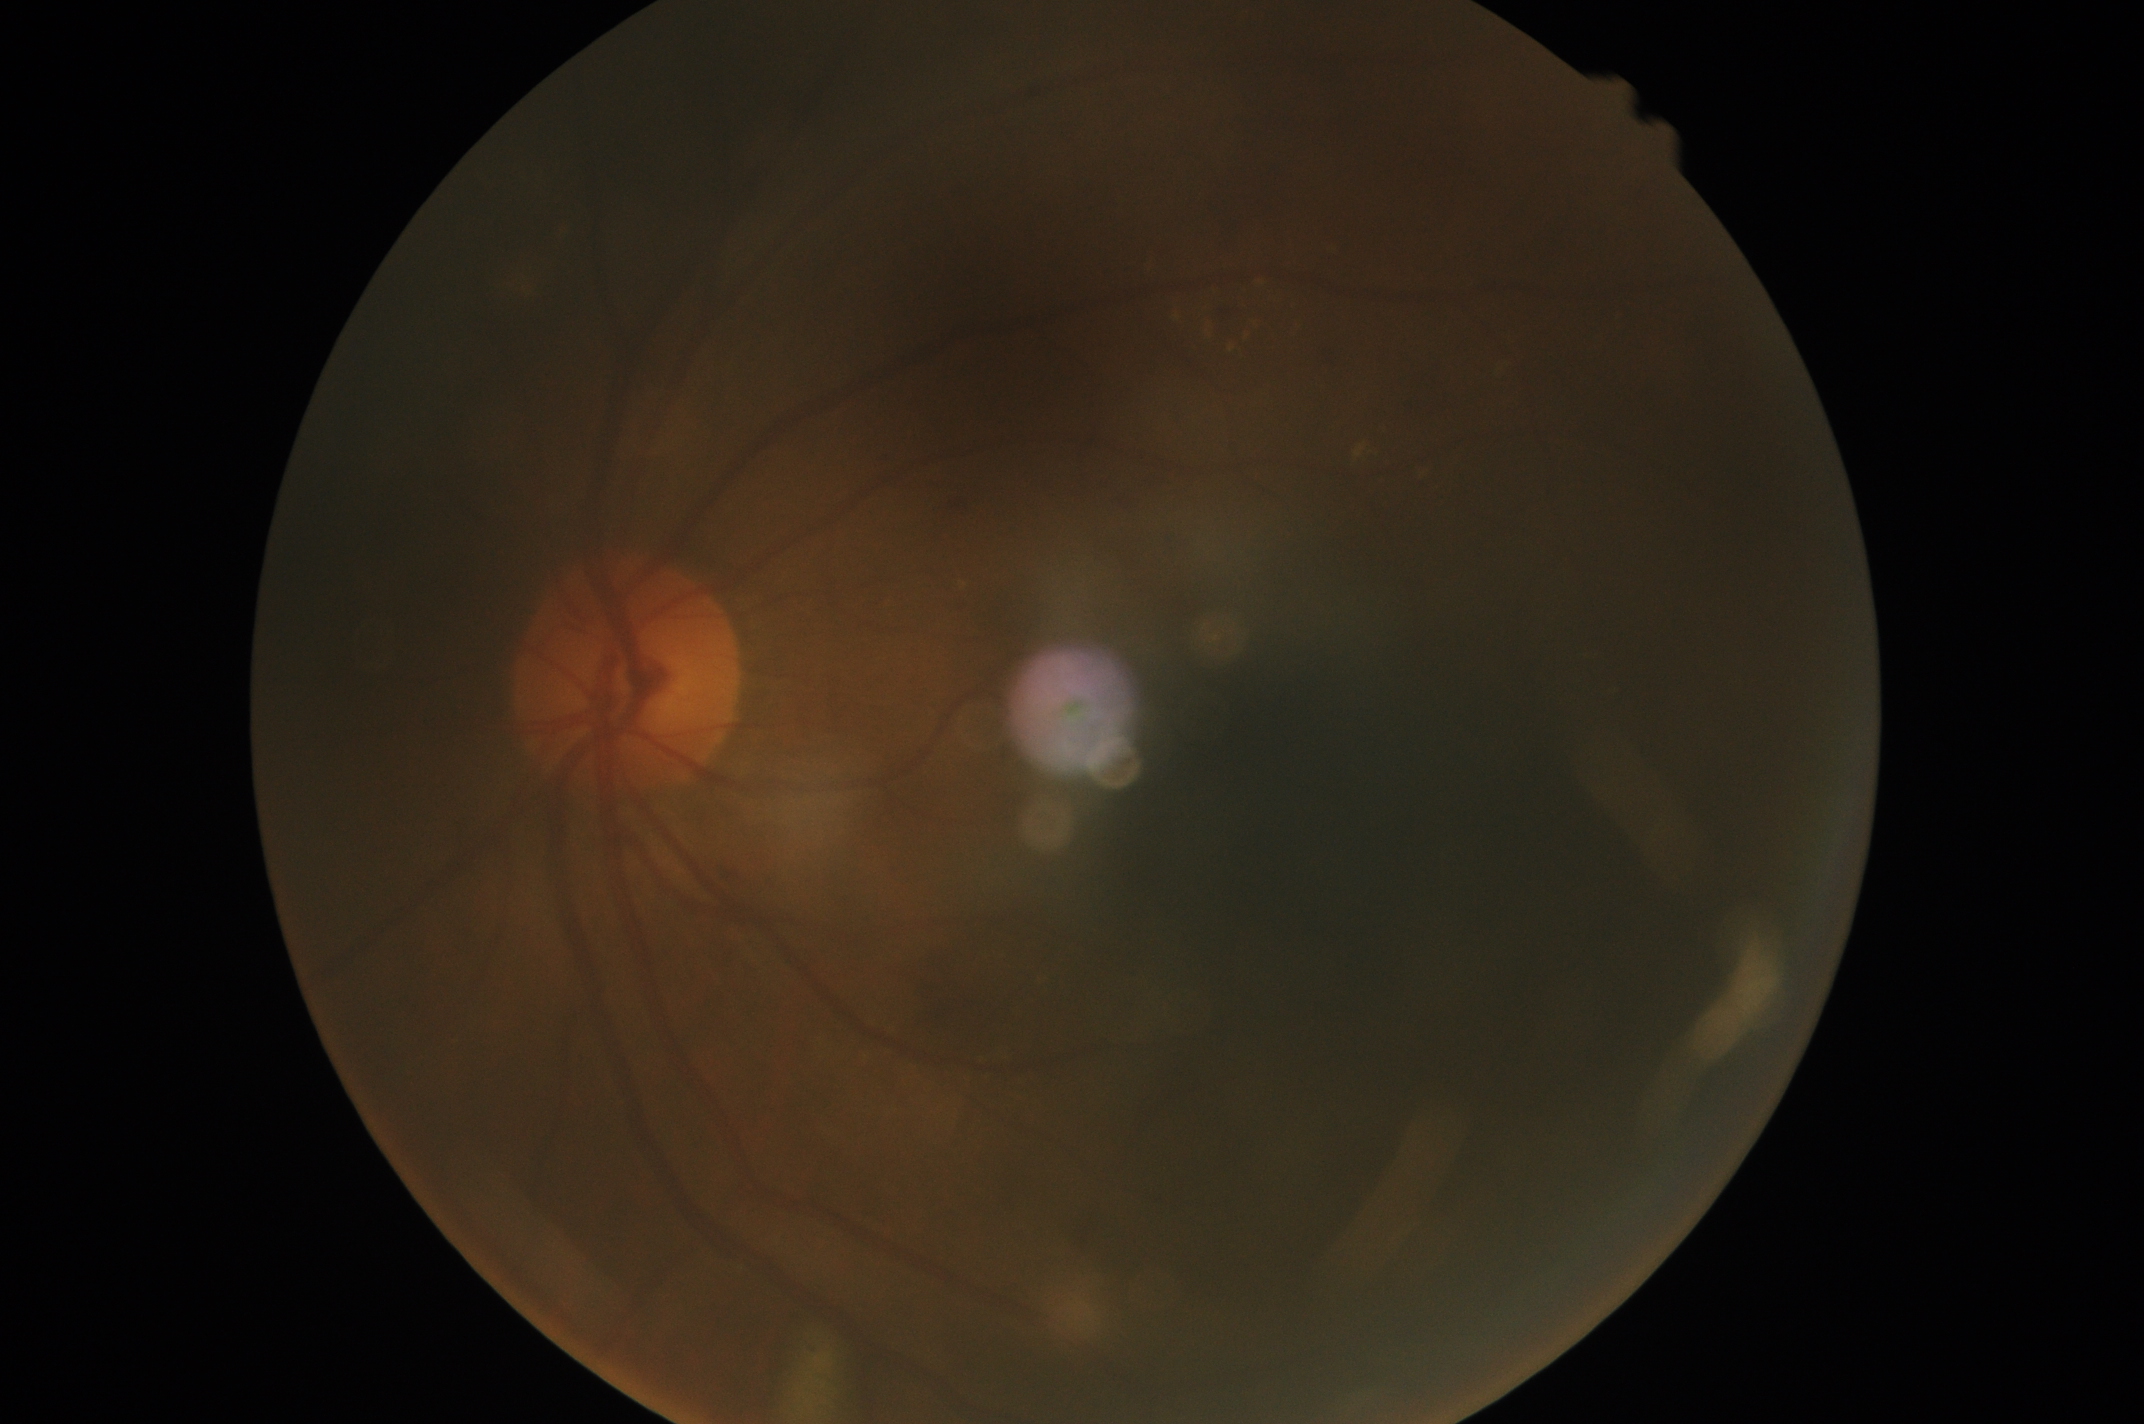
DR stage is moderate non-proliferative diabetic retinopathy (grade 2).